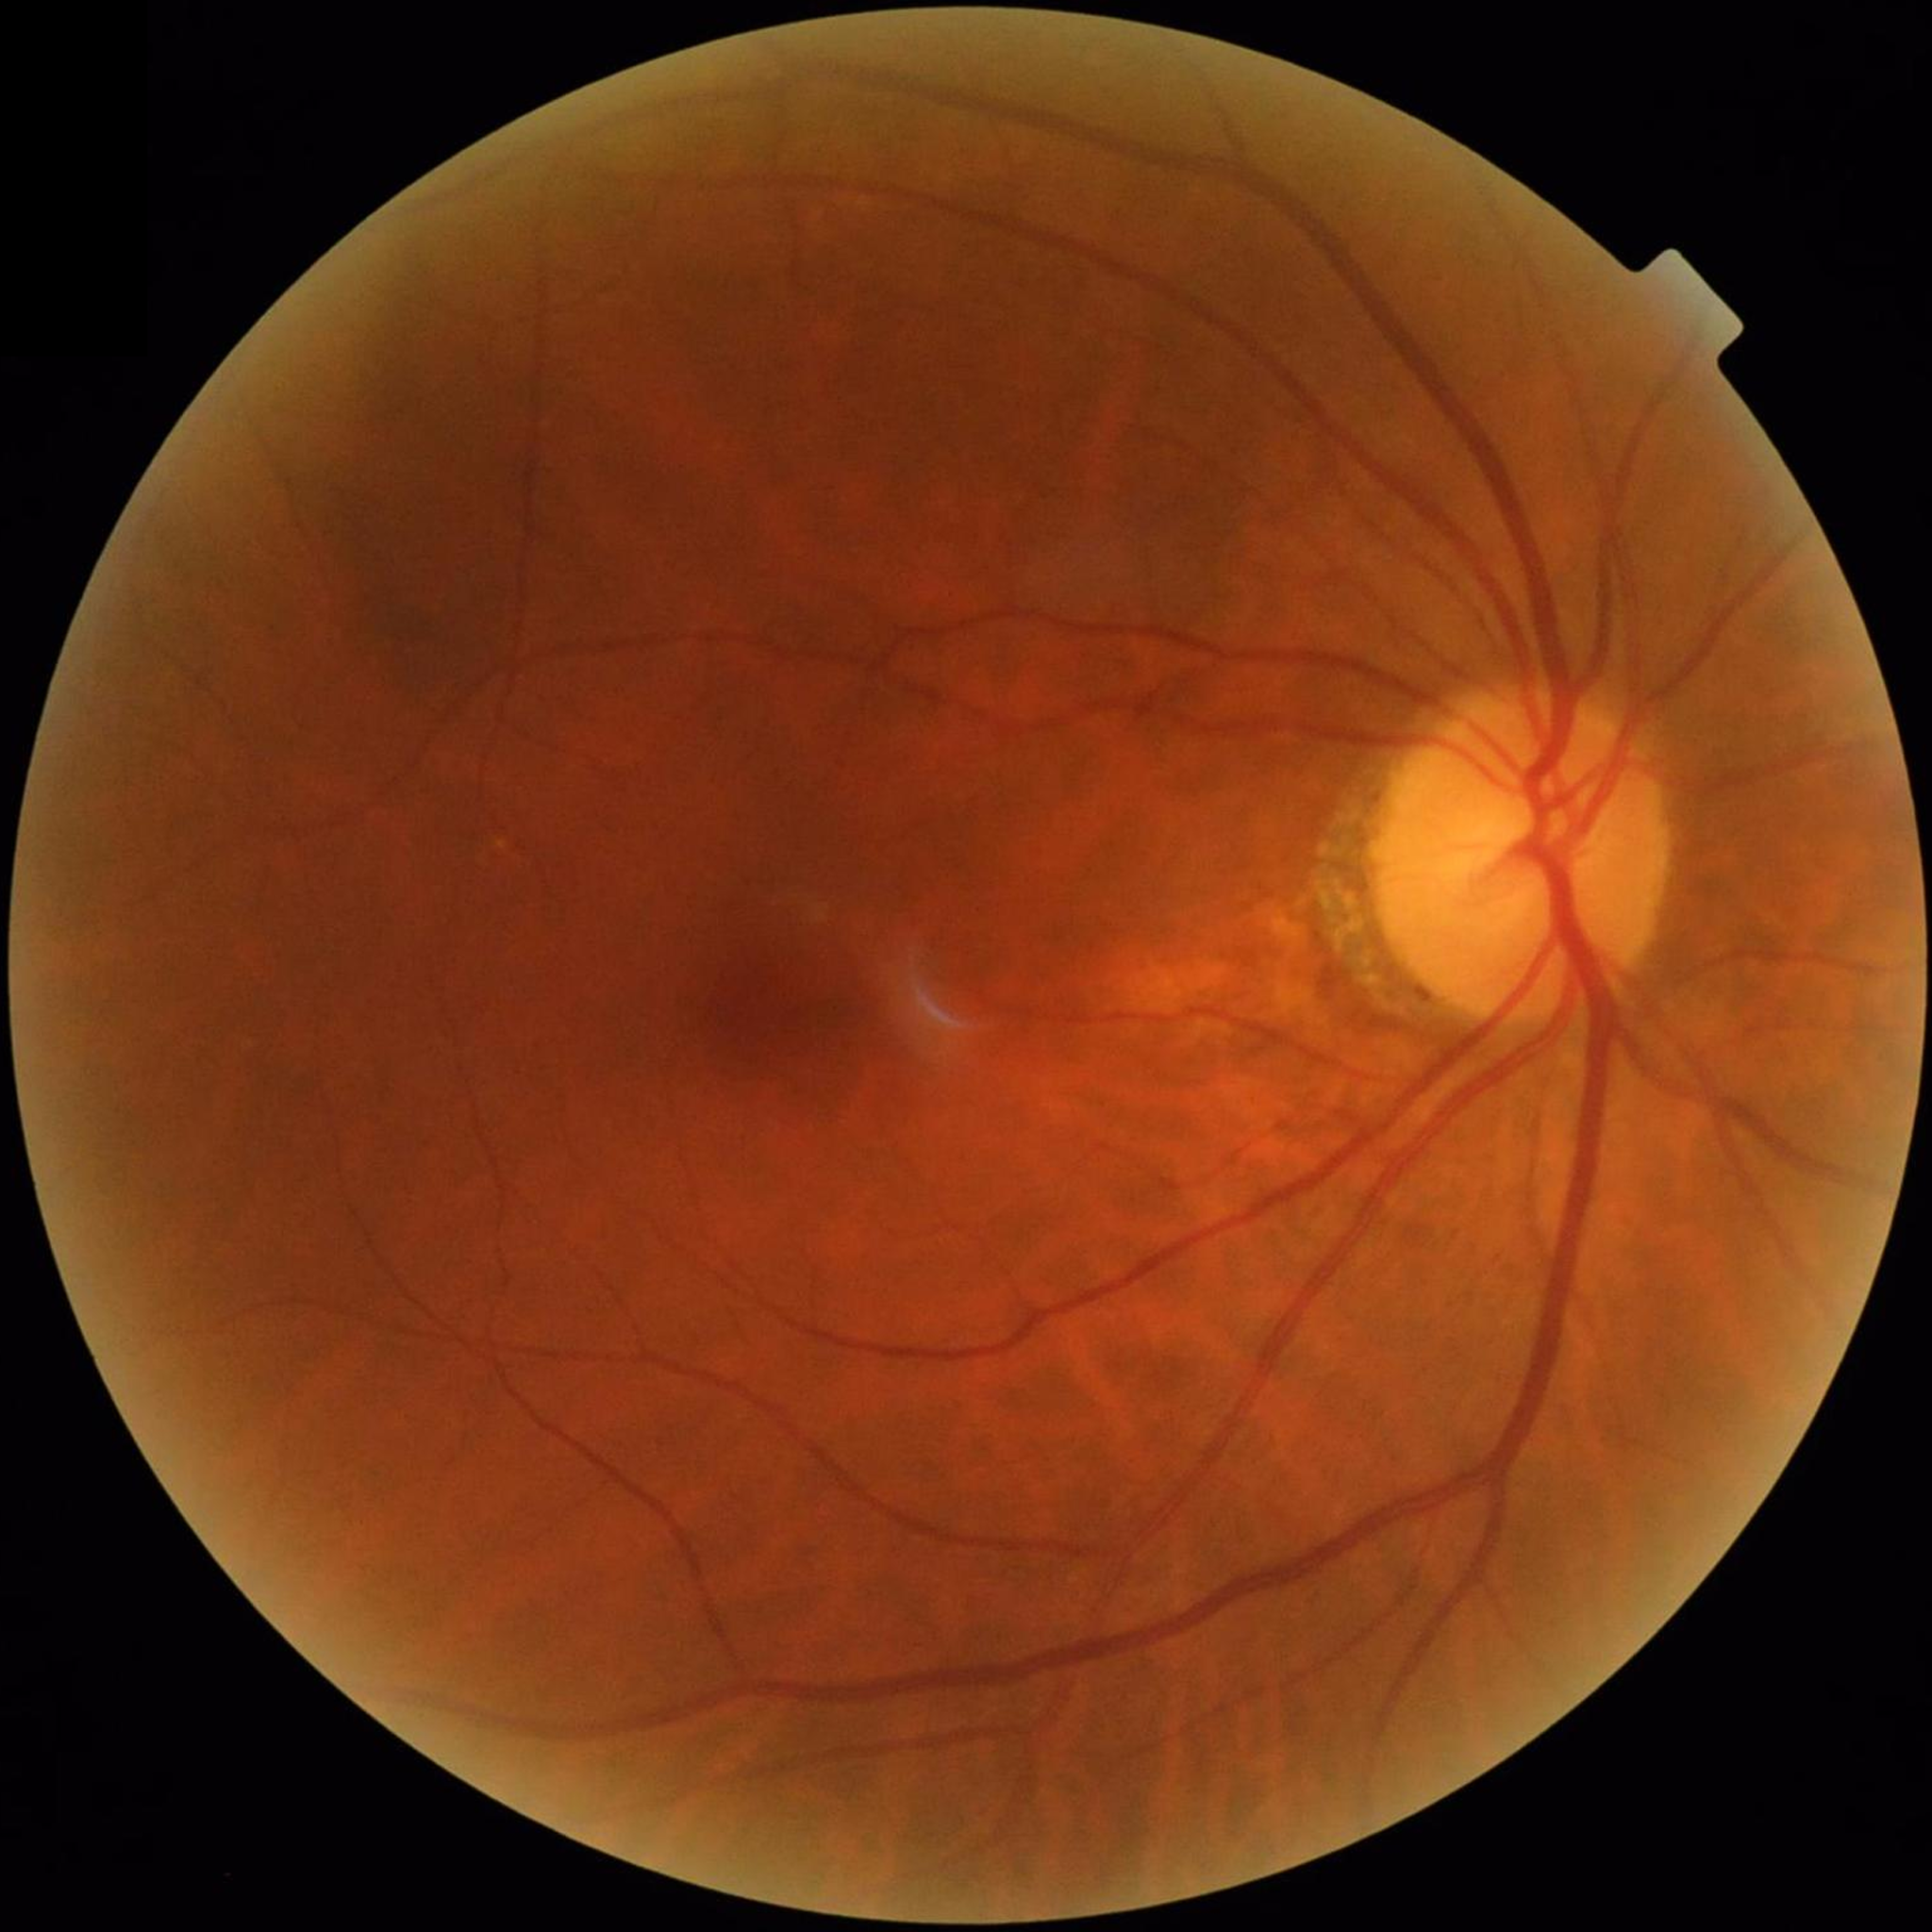
No signs of AMD, diabetic retinopathy, or glaucoma.